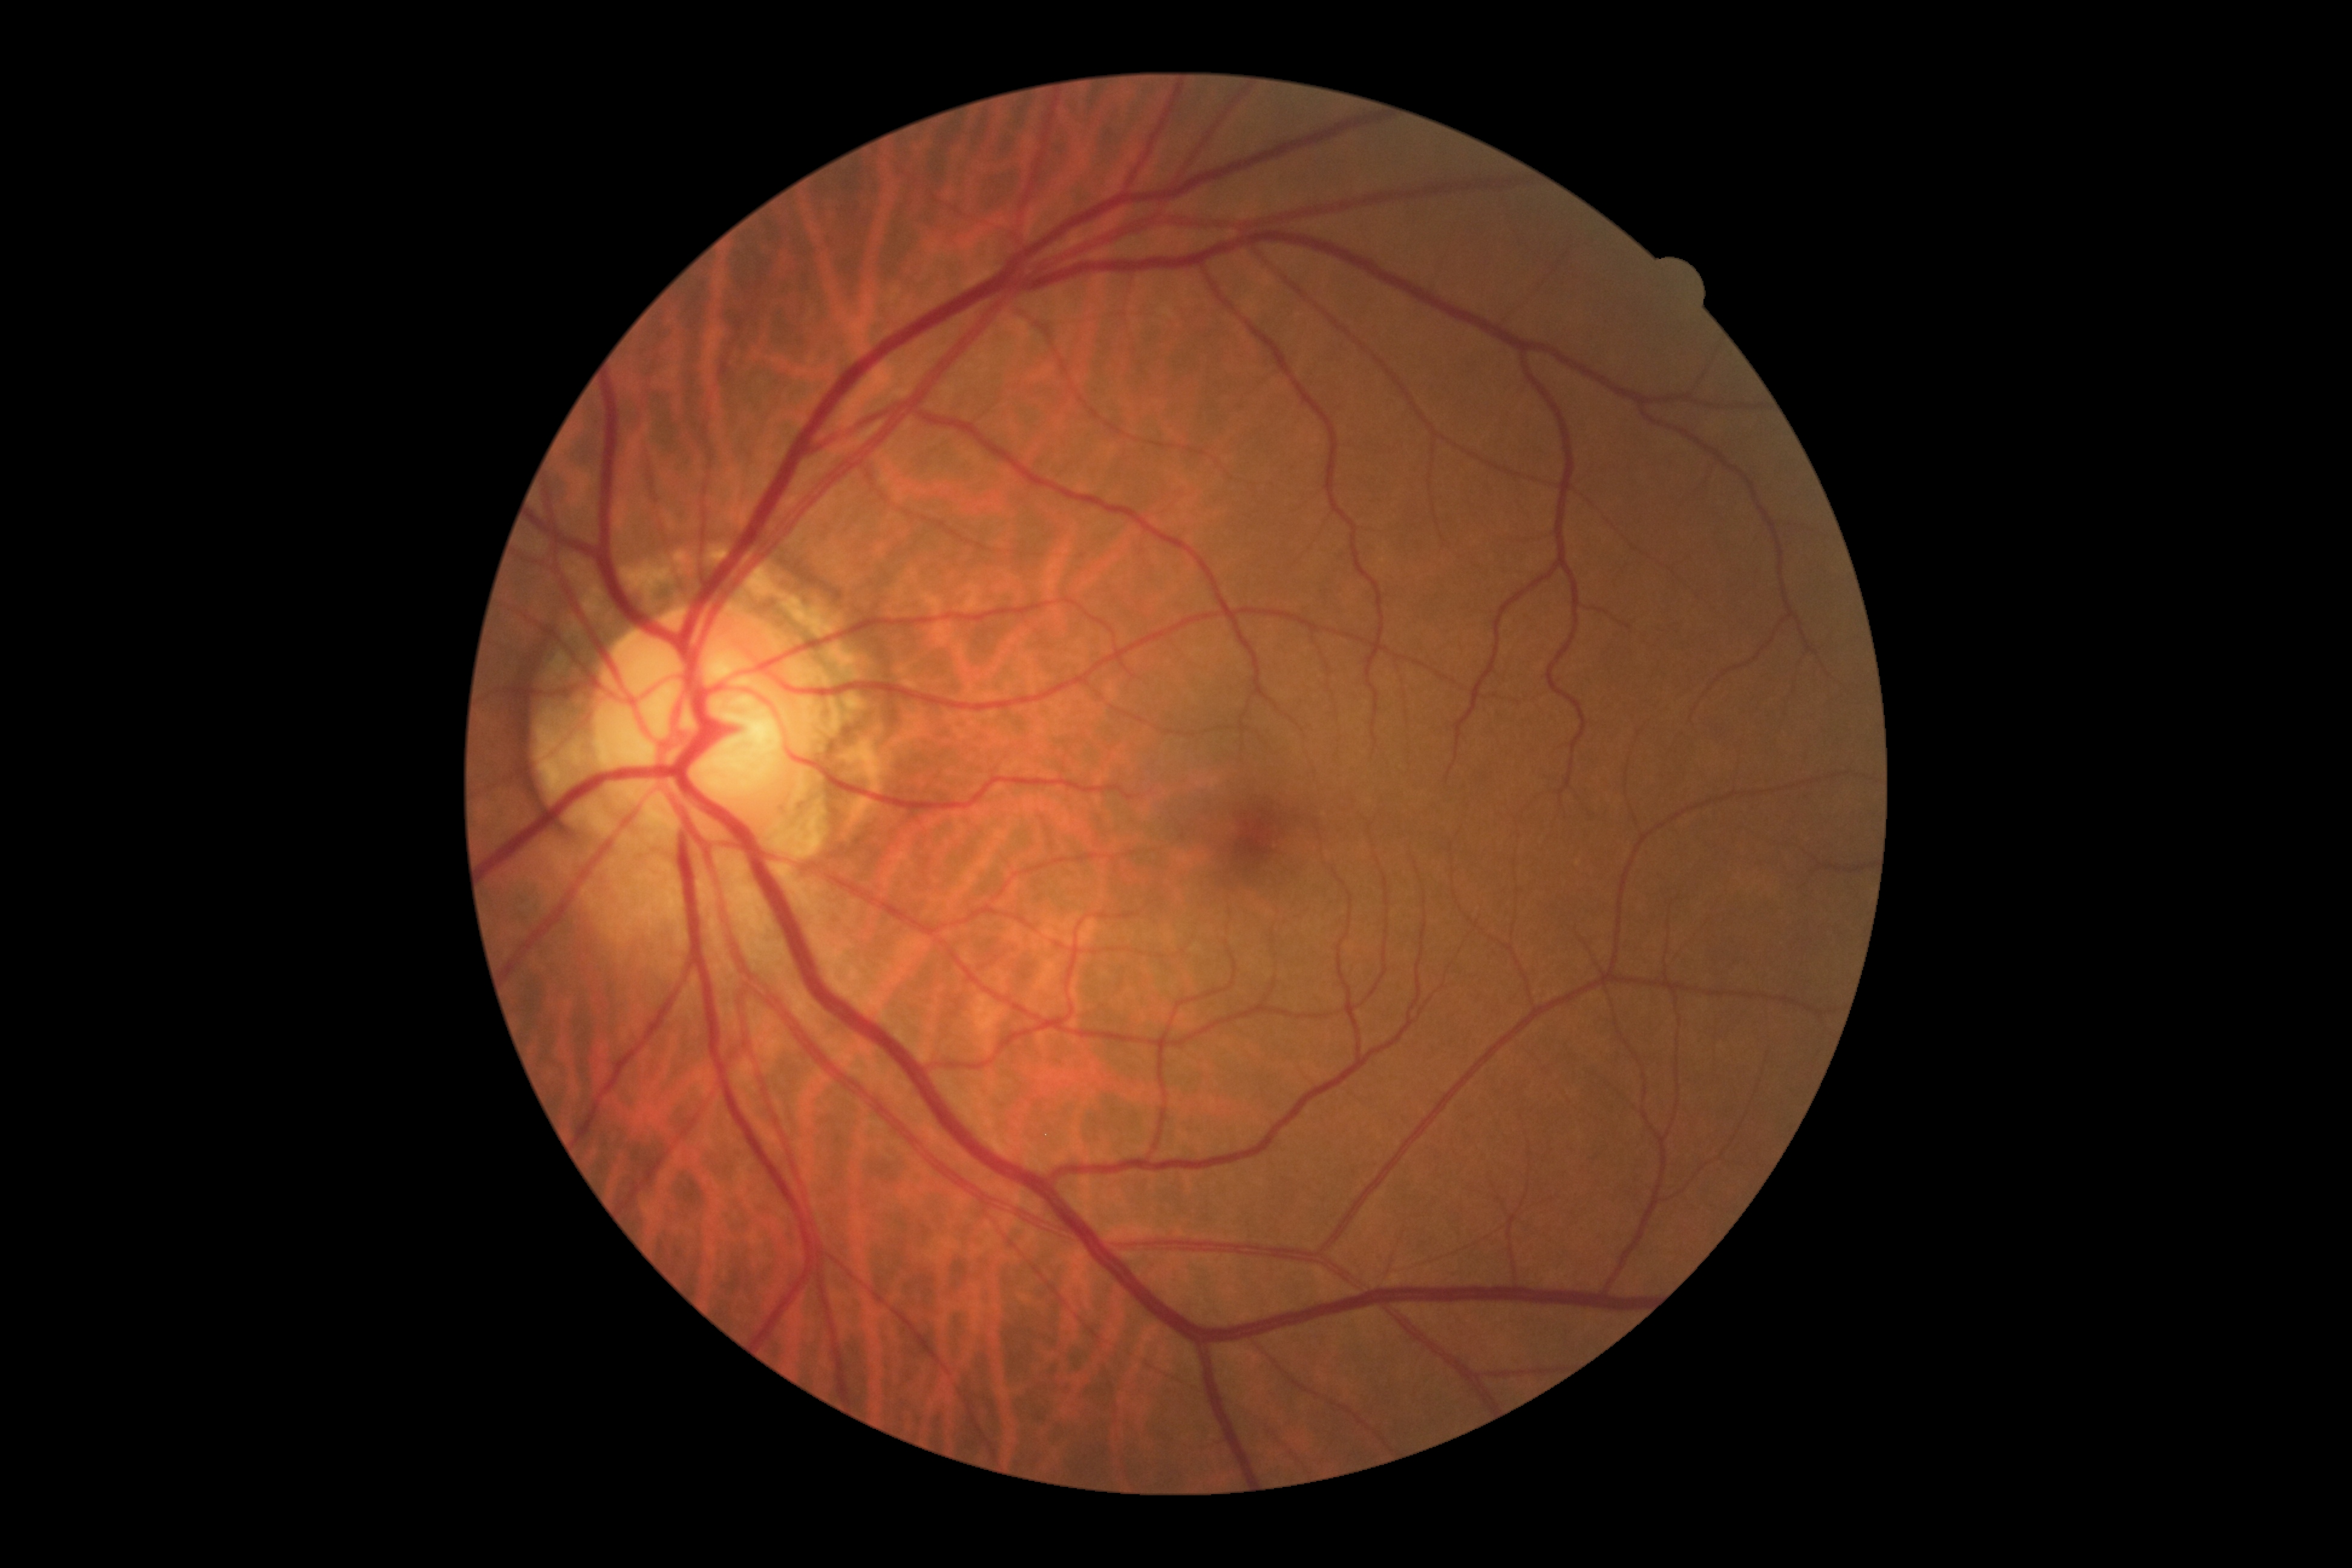
No DR findings. DR: grade 0 (no apparent retinopathy).